45° field of view: 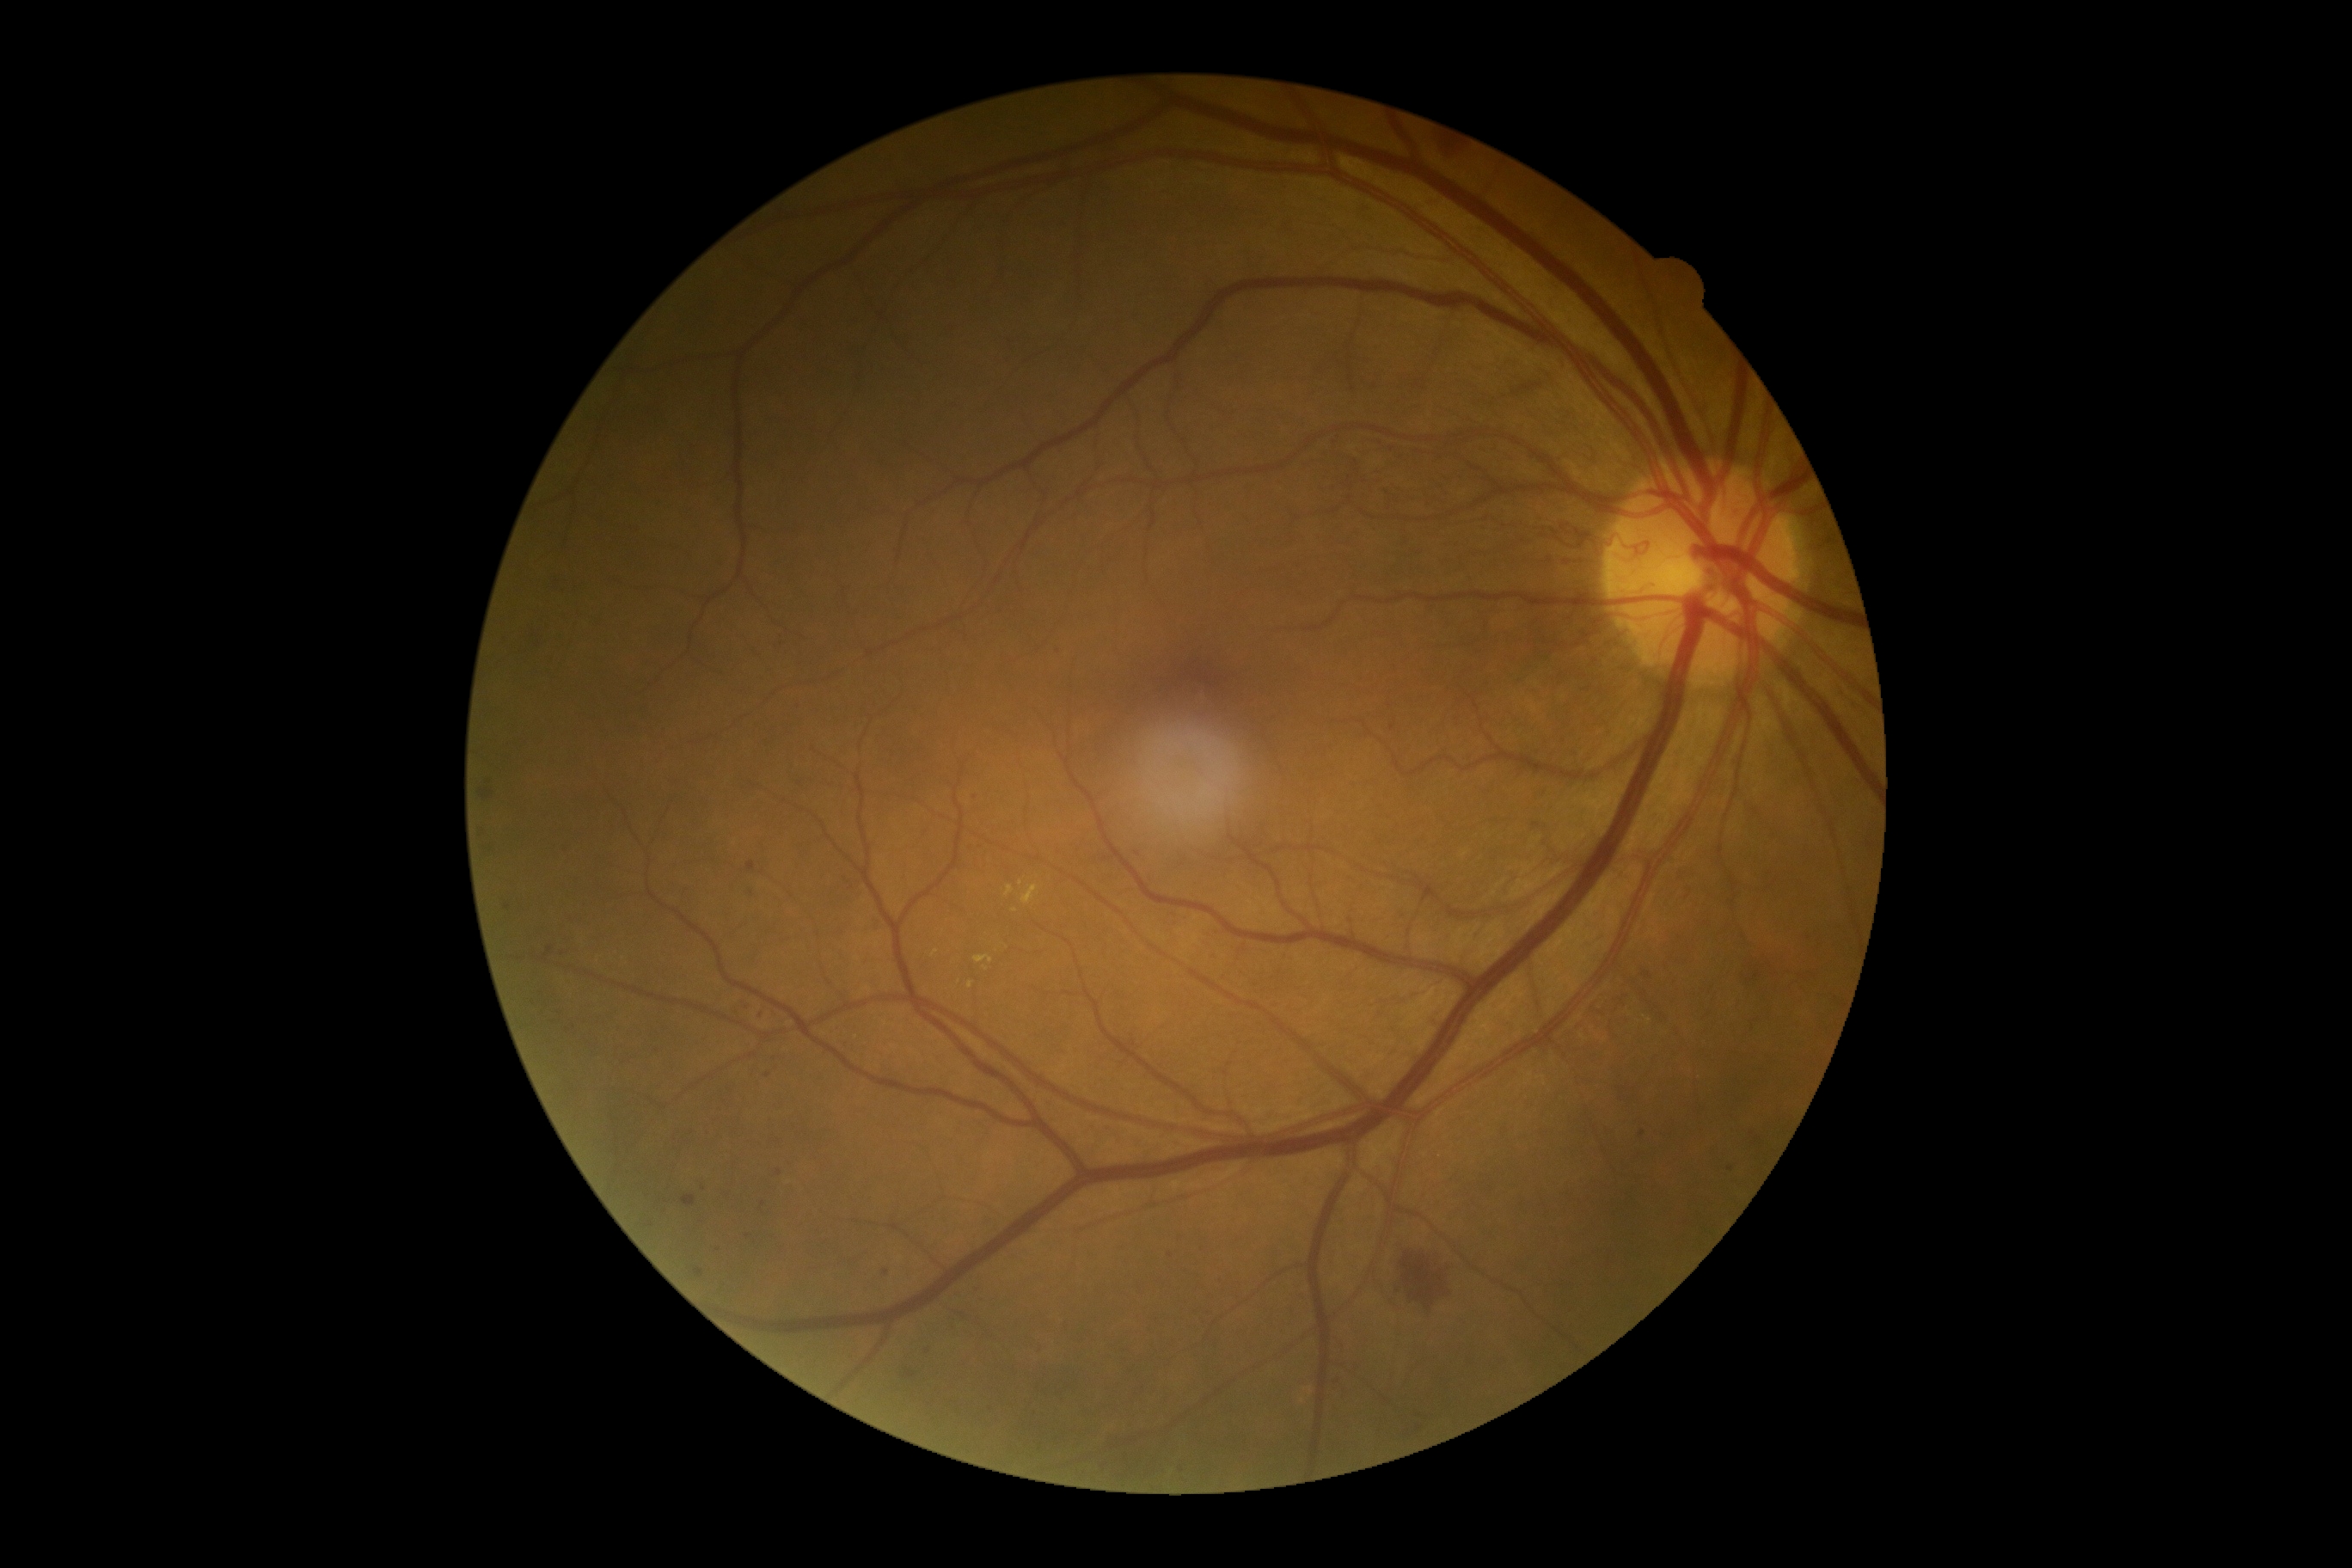

DR grade: 3 — more than 20 intraretinal hemorrhages in each of 4 quadrants, definite venous beading in 2 or more quadrants, or prominent intraretinal microvascular abnormalities in 1 or more quadrants, with no signs of proliferative retinopathy.